Infant wide-field fundus photograph · image size 640x480.
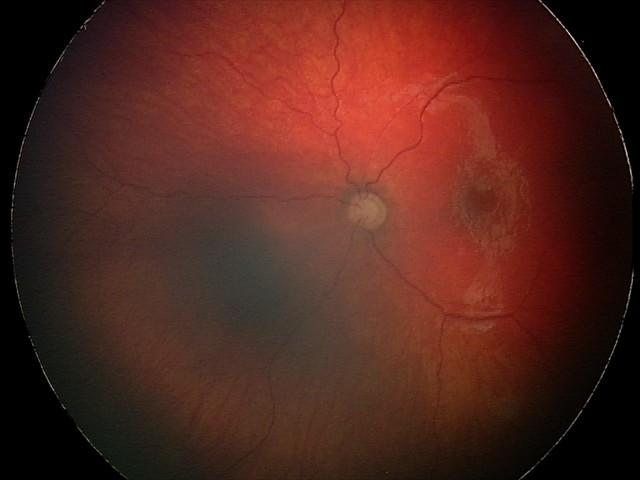

Screening diagnosis: optic nerve hypoplasia.